Fundus photo; 1504 by 1000 pixels.
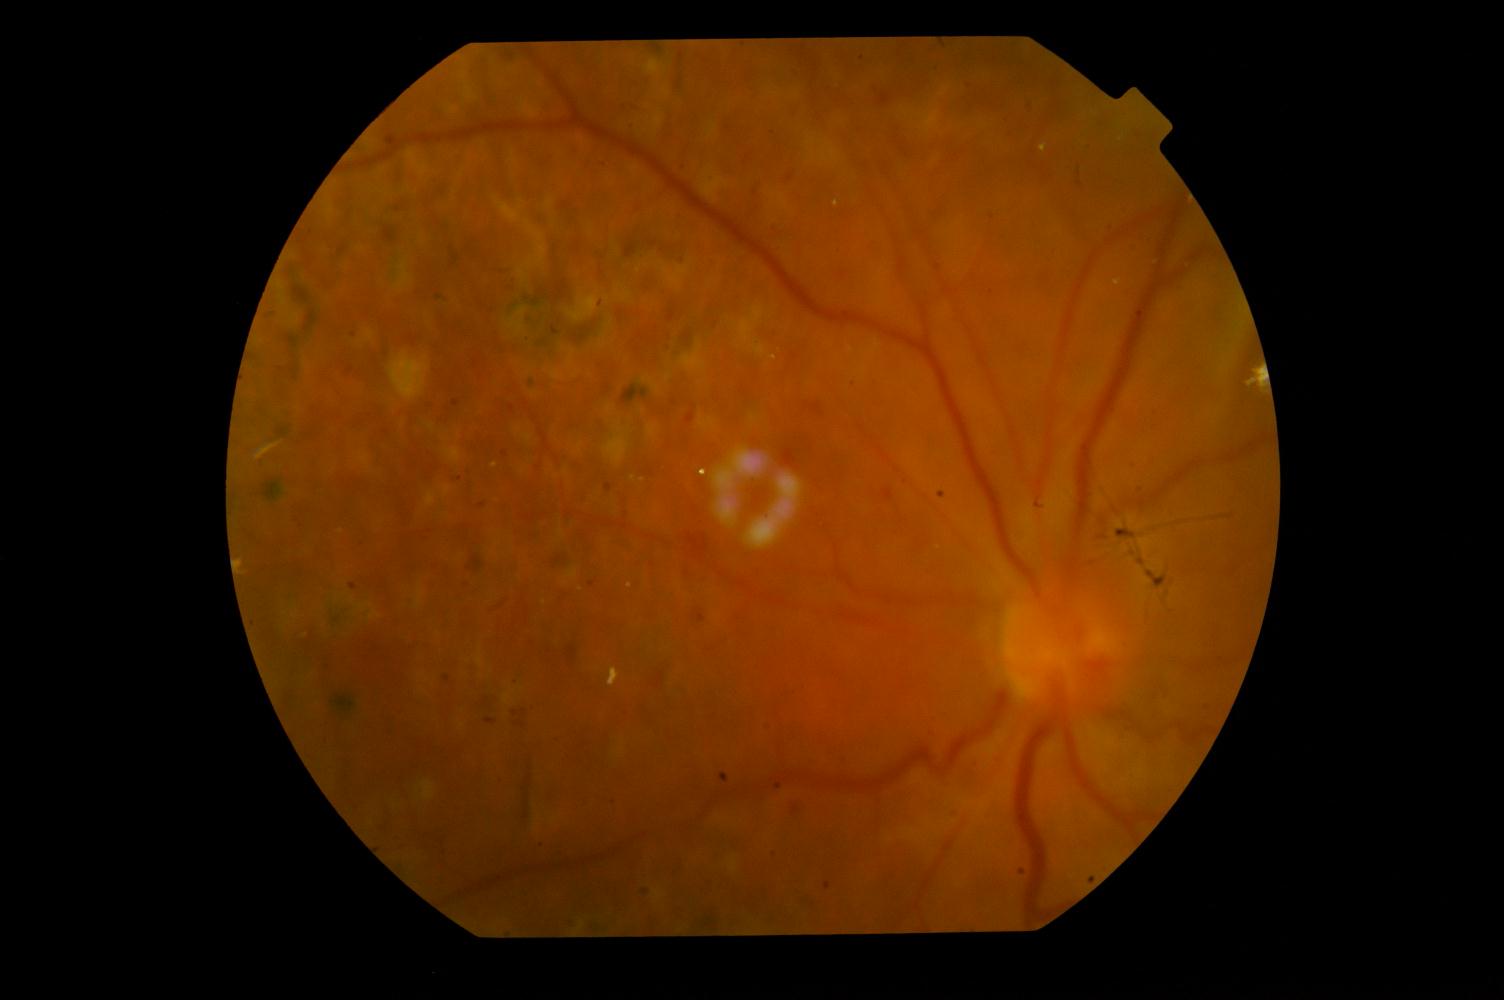 Abnormalities:
- diabetic retinopathy